2352x1568px; fundus photo; FOV: 45 degrees: 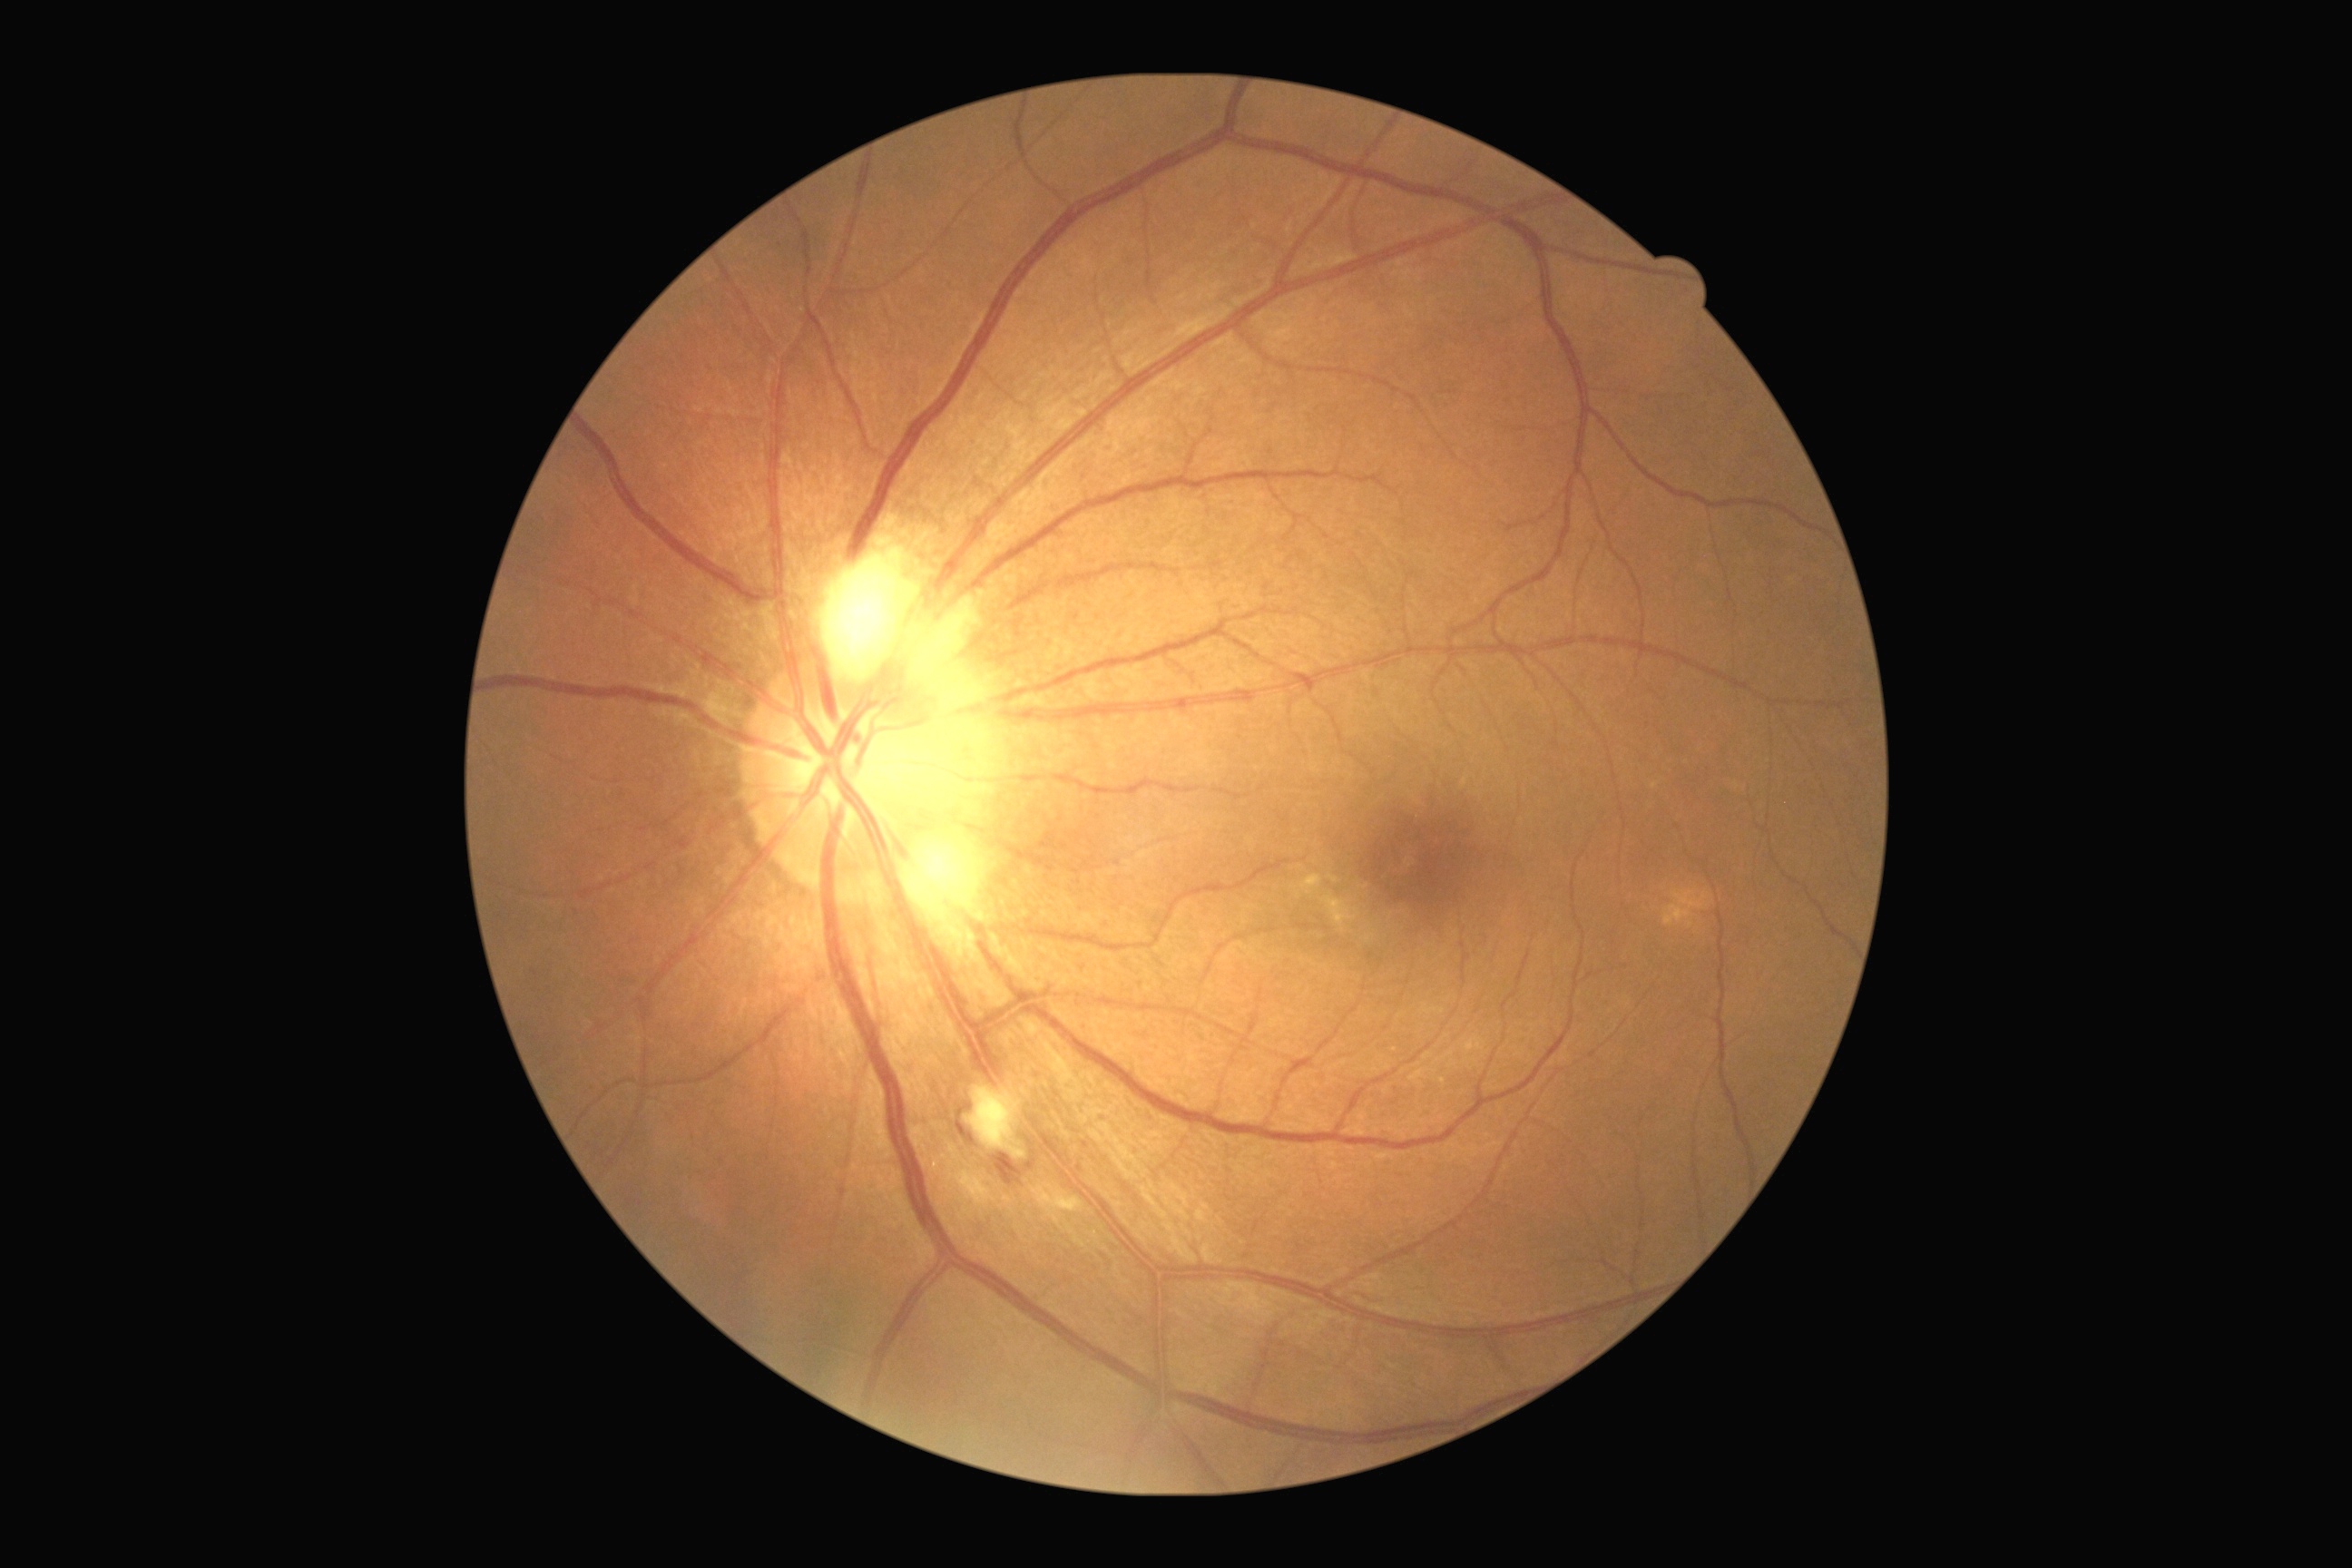

{
  "dr_grade": "2/4 — more than just microaneurysms but less than severe NPDR"
}